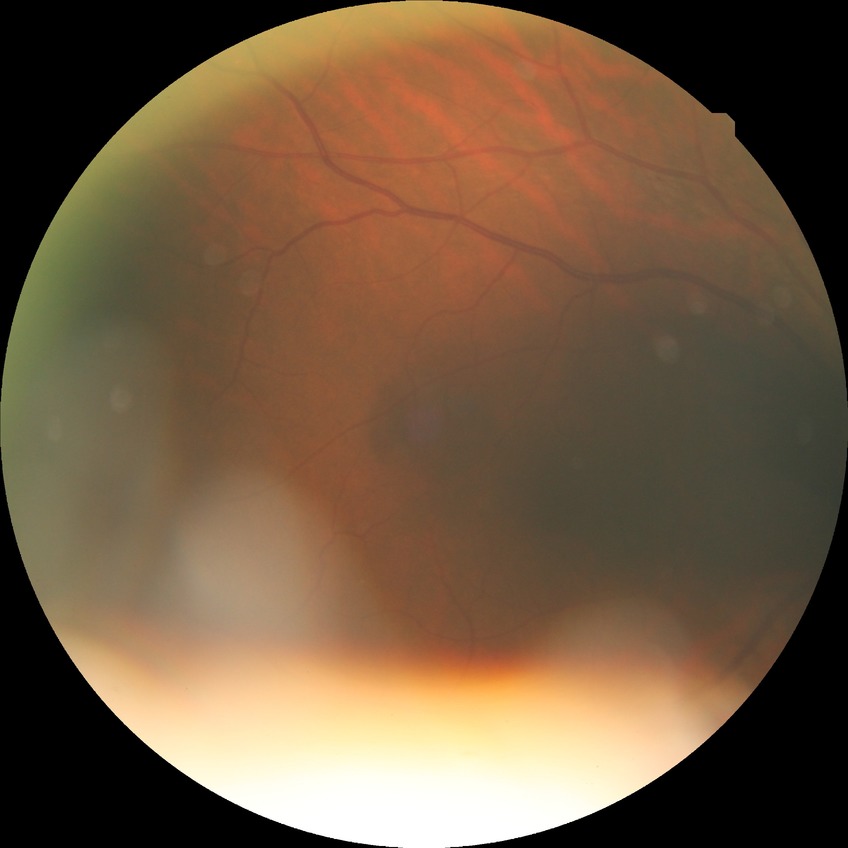

Diabetic retinopathy (DR) is simple diabetic retinopathy (SDR).